Image size 848x848; modified Davis grading; retinal fundus photograph; 45° FOV.
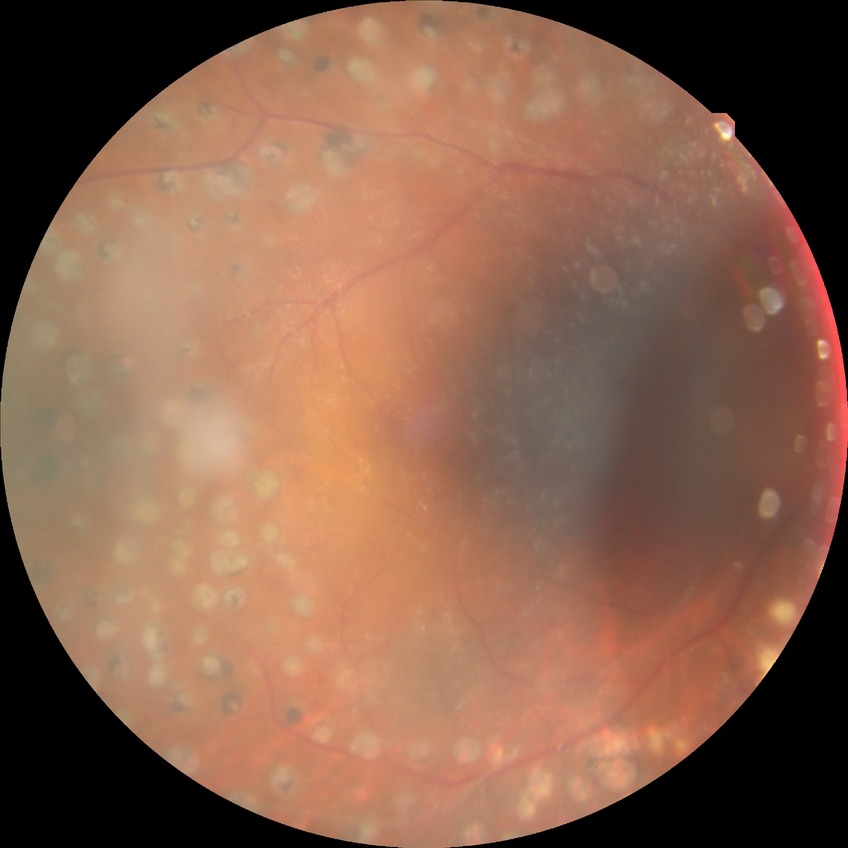

davis_grade: proliferative diabetic retinopathy (PDR)